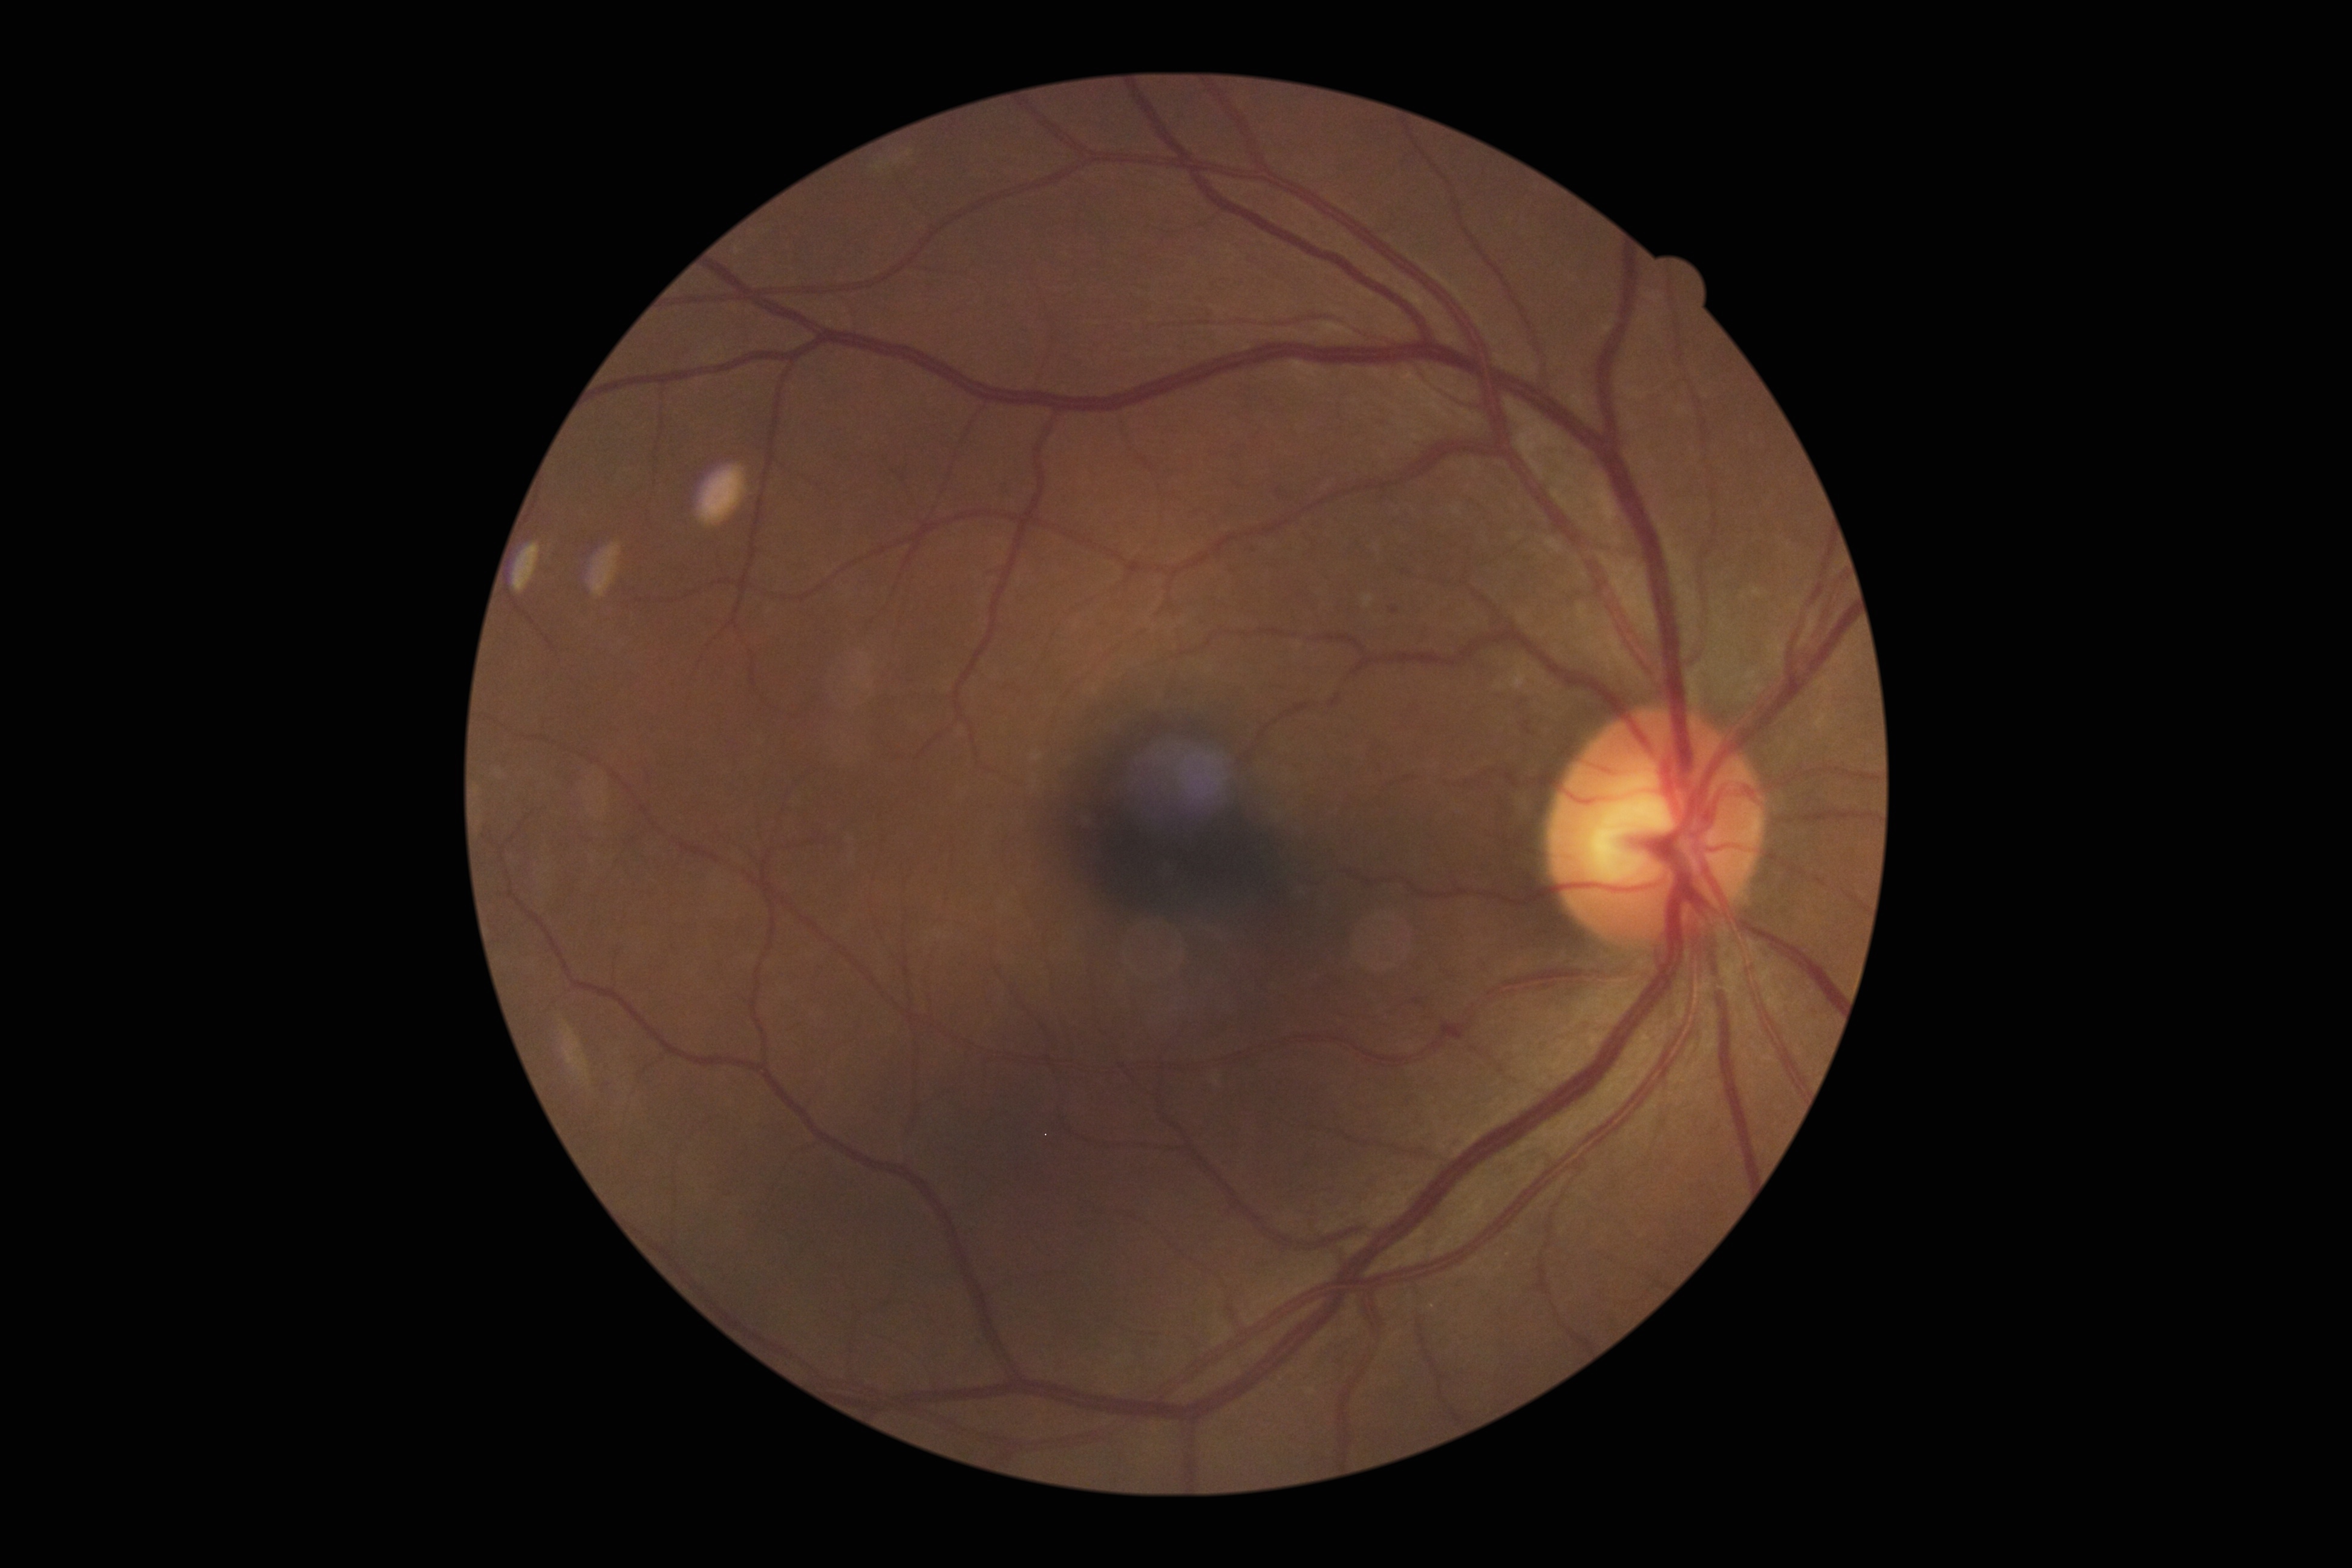
DR severity: 1/4.